Retinal fundus photograph.
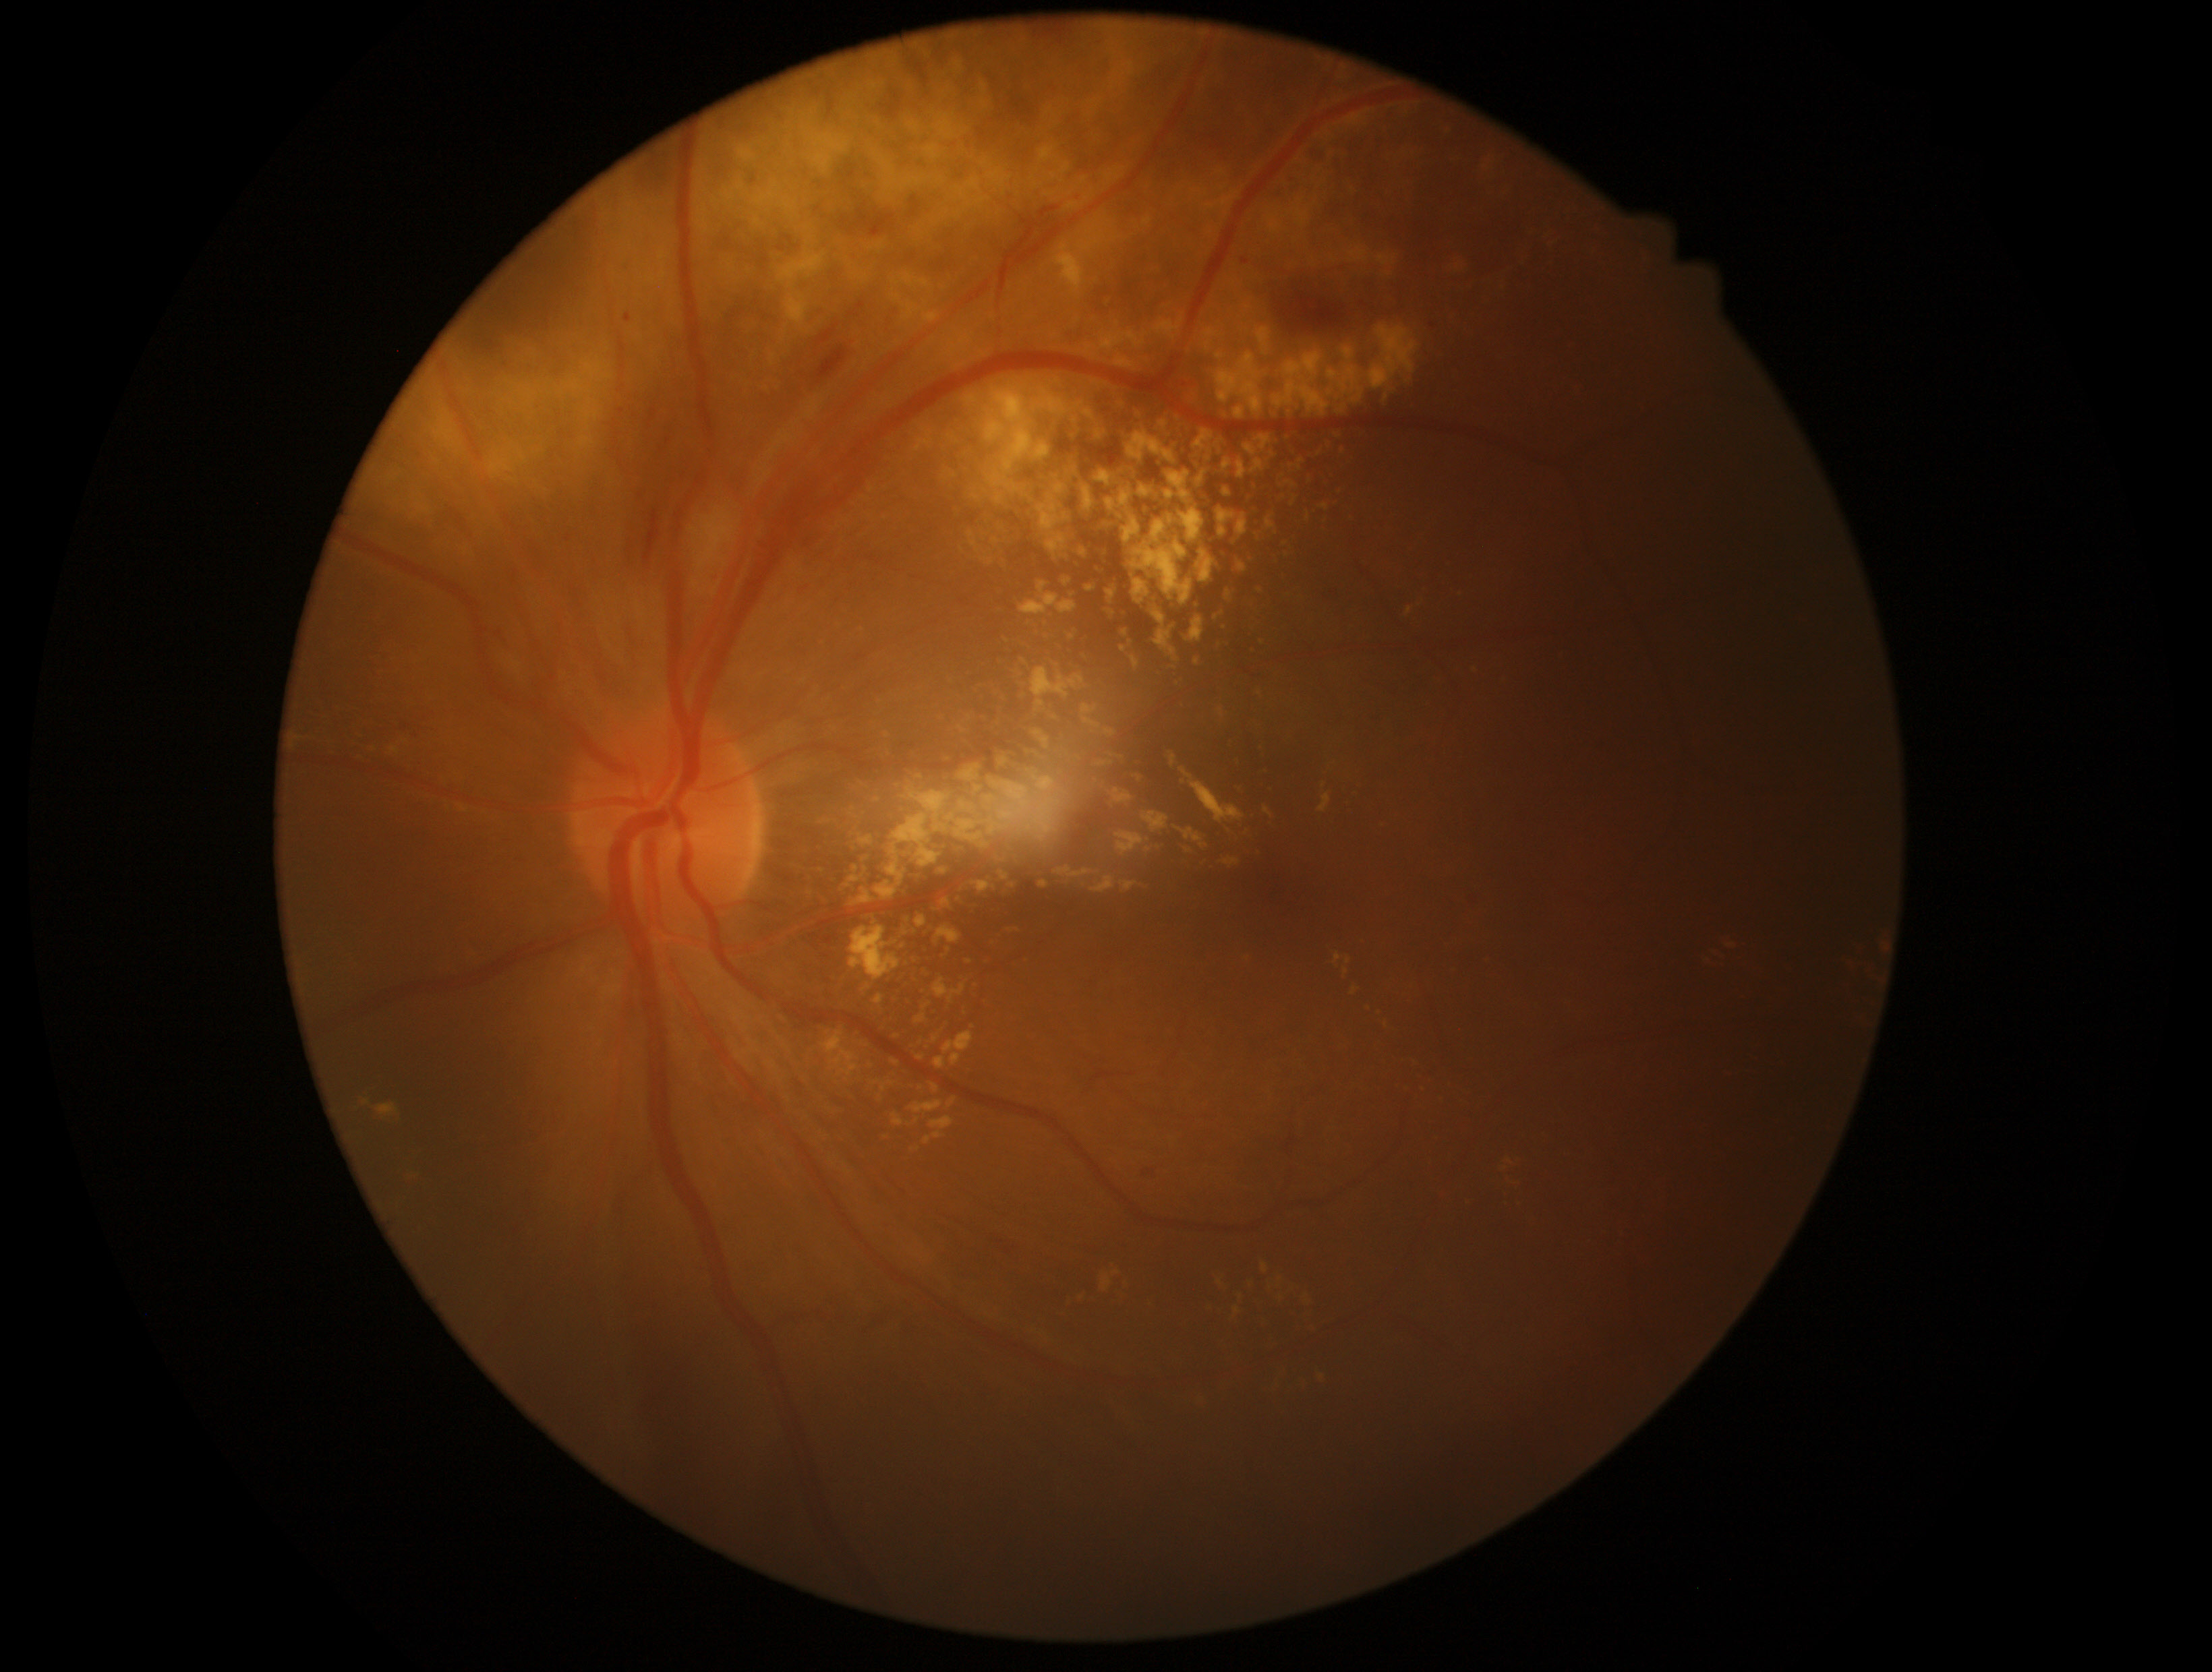 {
  "dr_grade": "moderate NPDR (grade 2) — more than just microaneurysms but less than severe NPDR",
  "dr_category": "non-proliferative diabetic retinopathy"
}